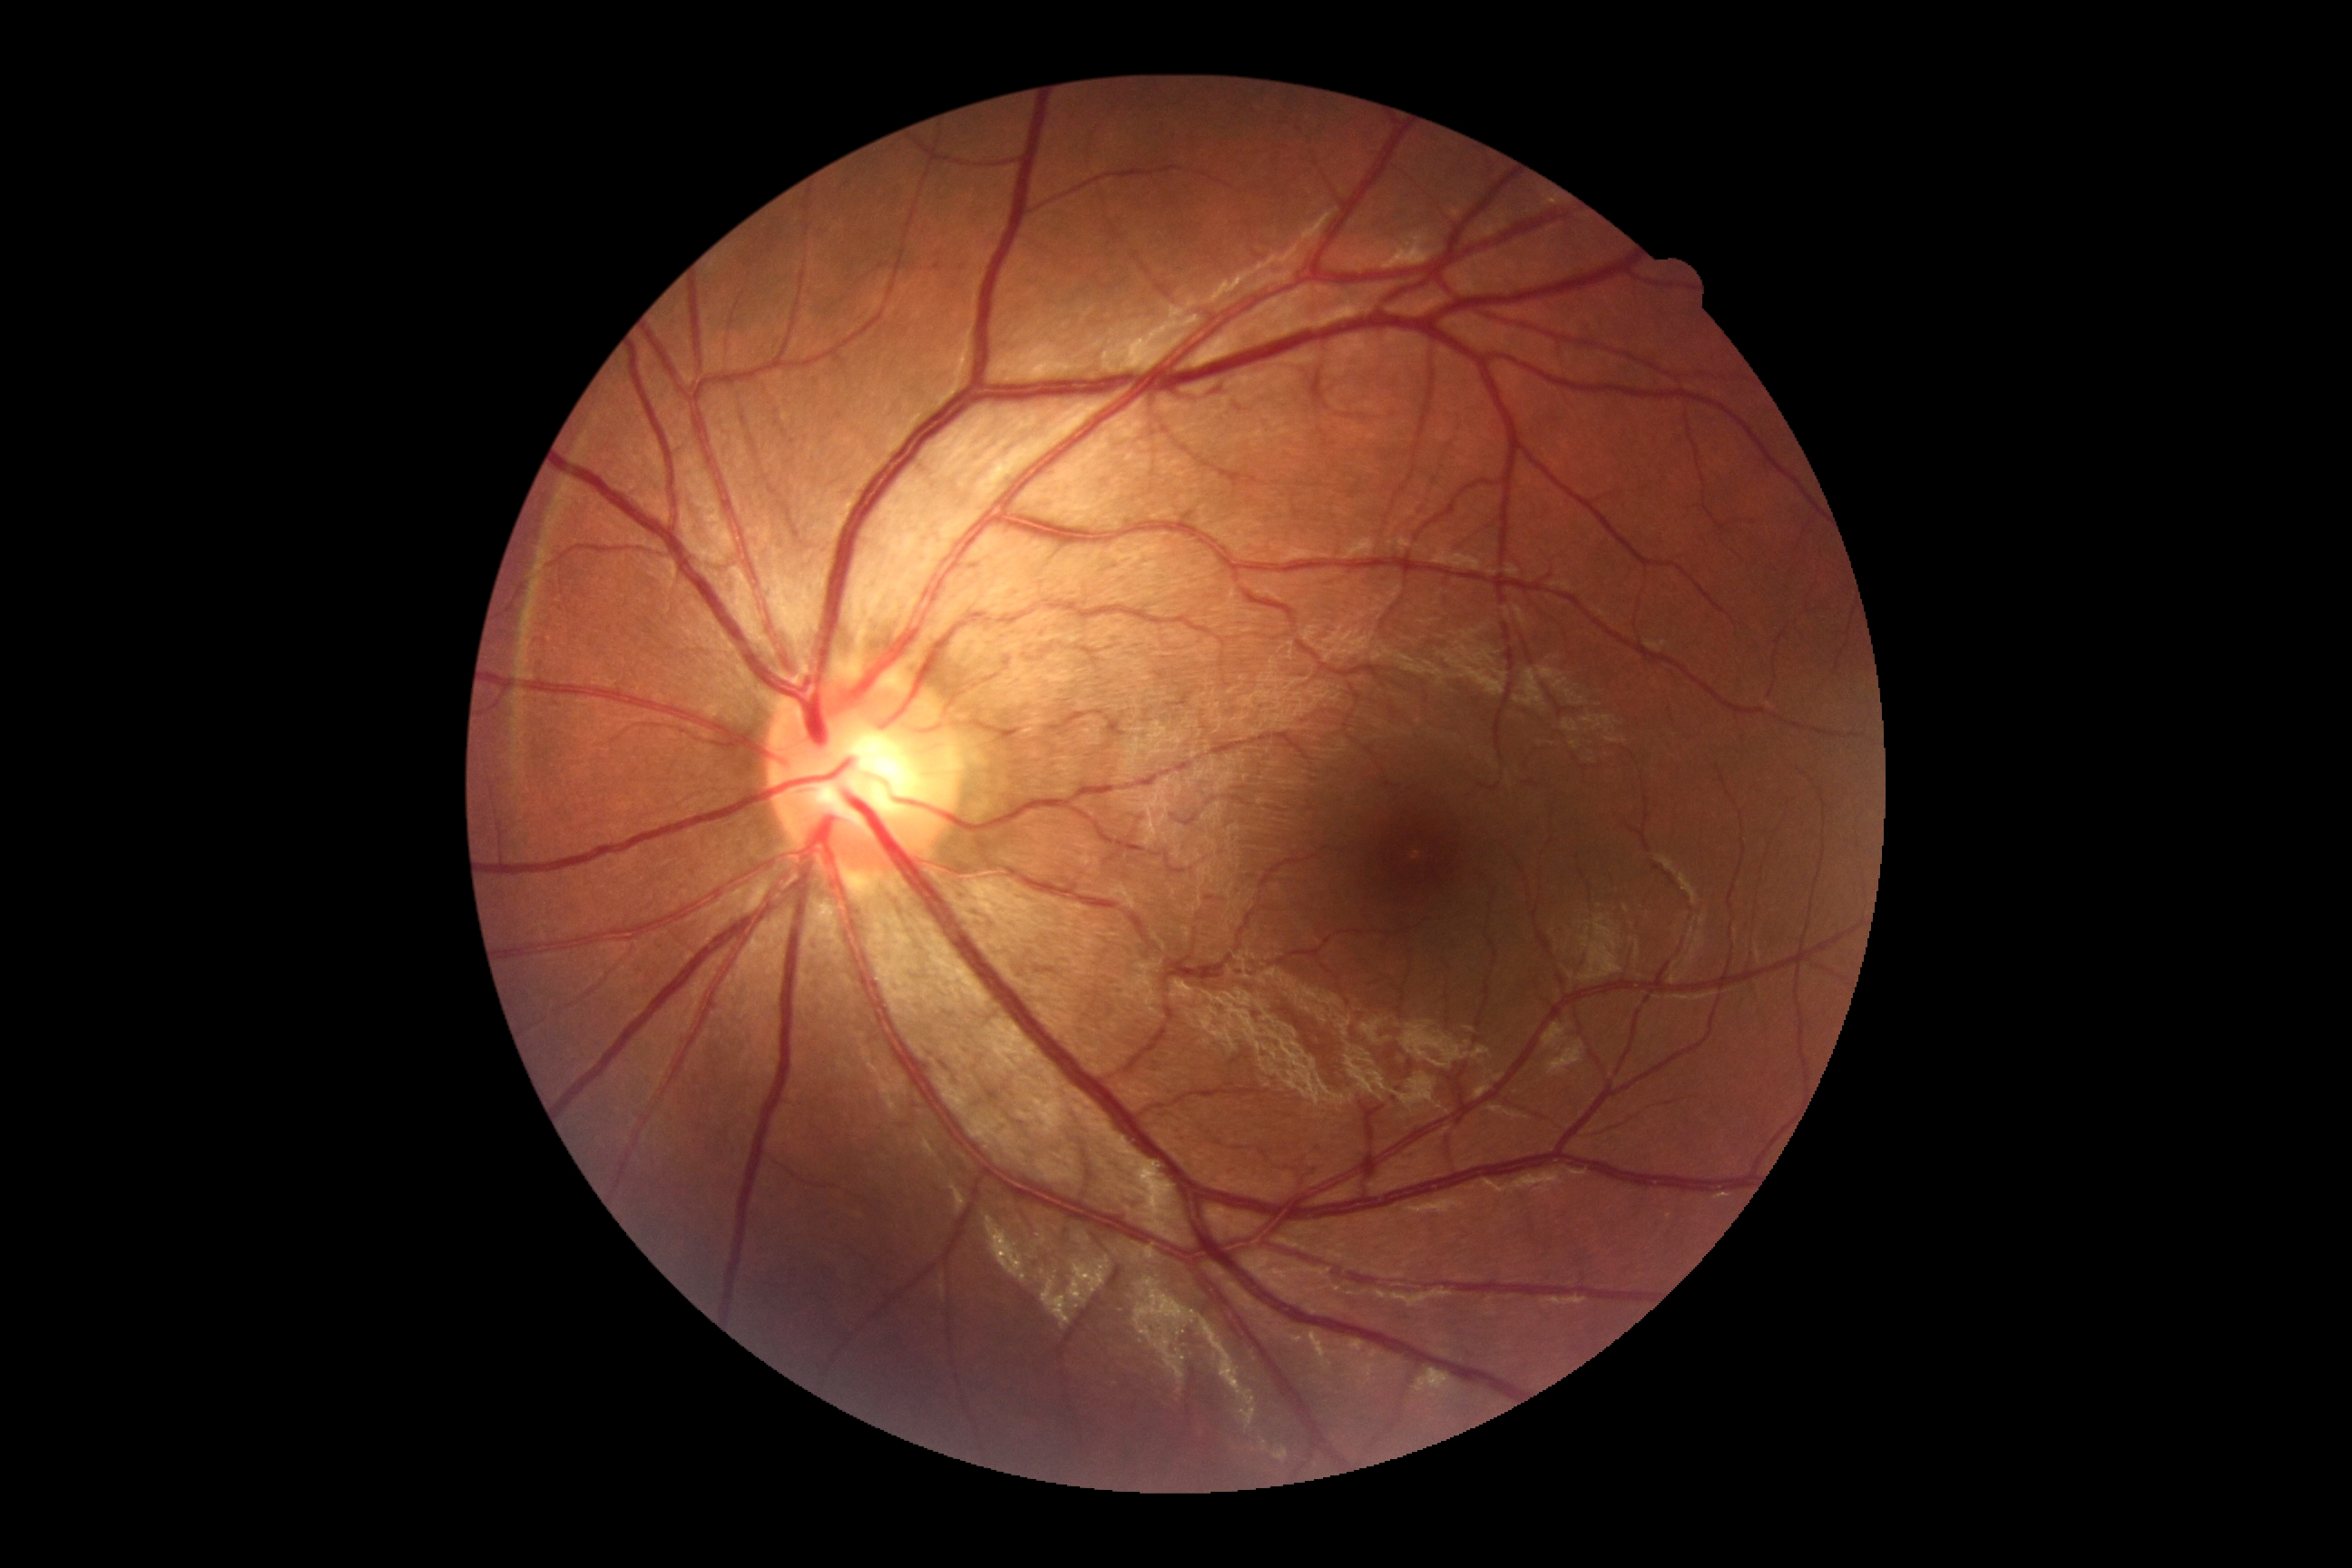
DR is no apparent diabetic retinopathy (grade 0).